FOV: 45 degrees:
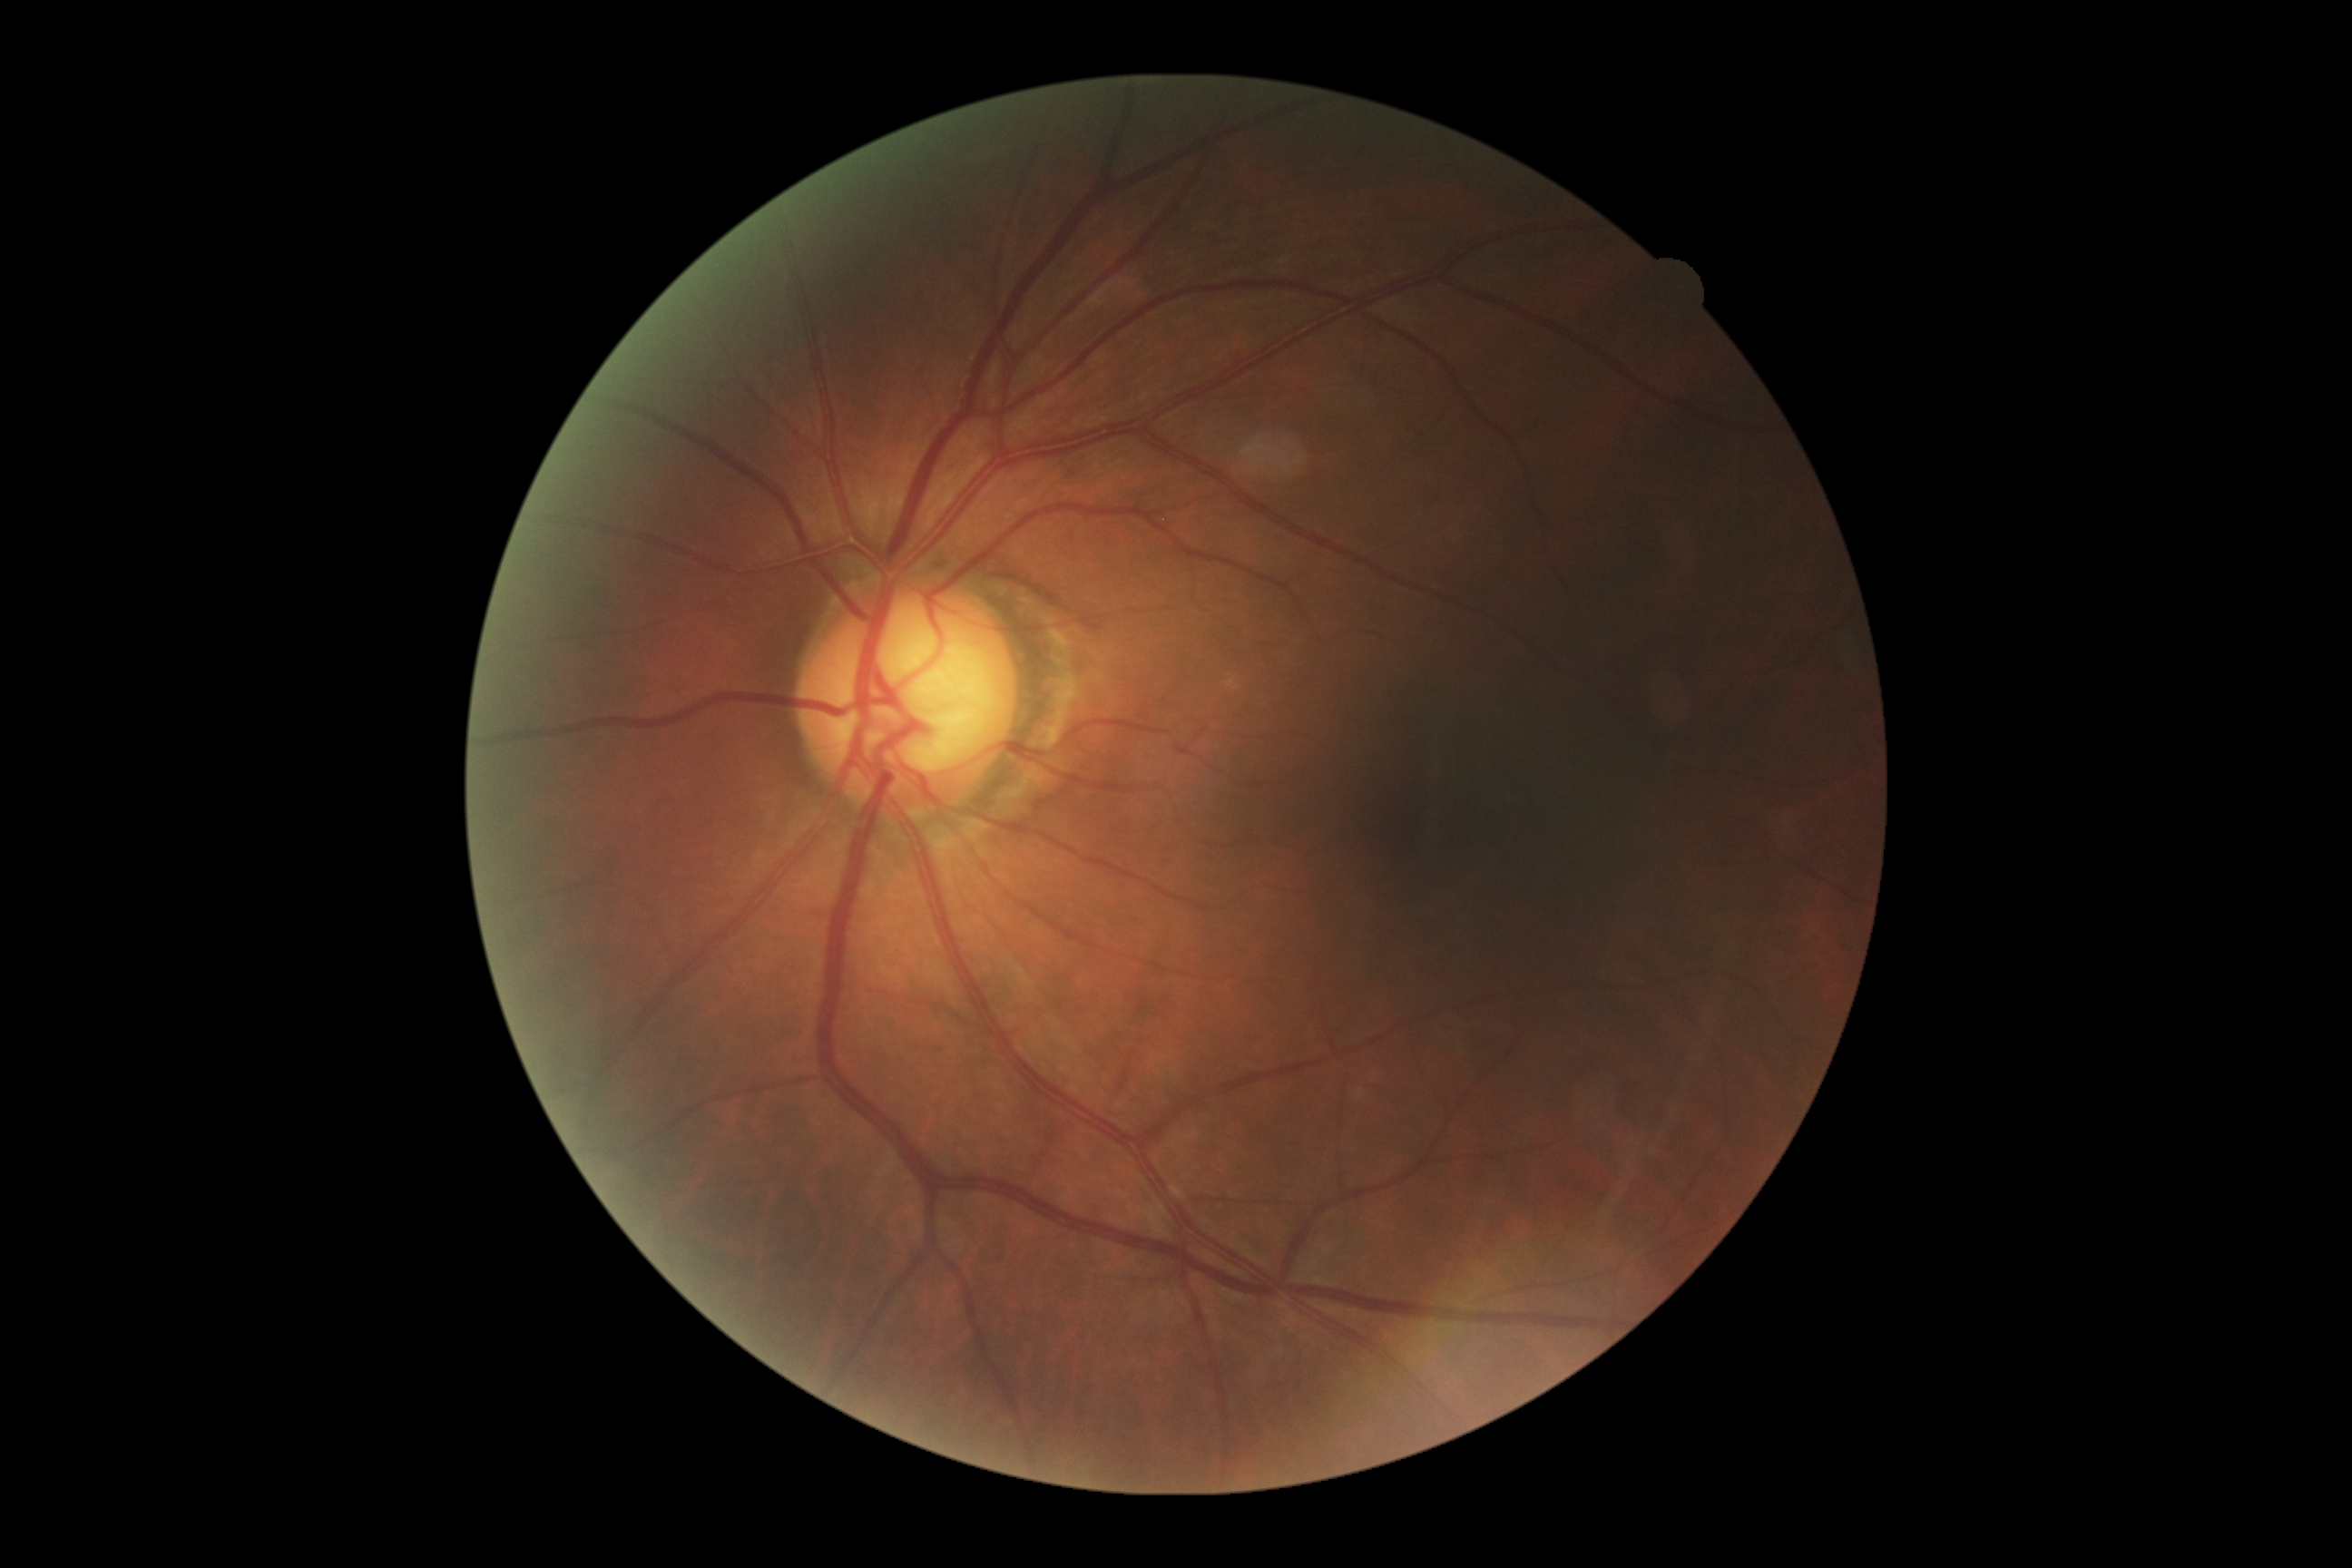 Retinopathy: 0/4.